No pharmacologic dilation · 848x848 · graded on the modified Davis scale · NIDEK AFC-230 fundus camera · 45° field of view · posterior pole photograph.
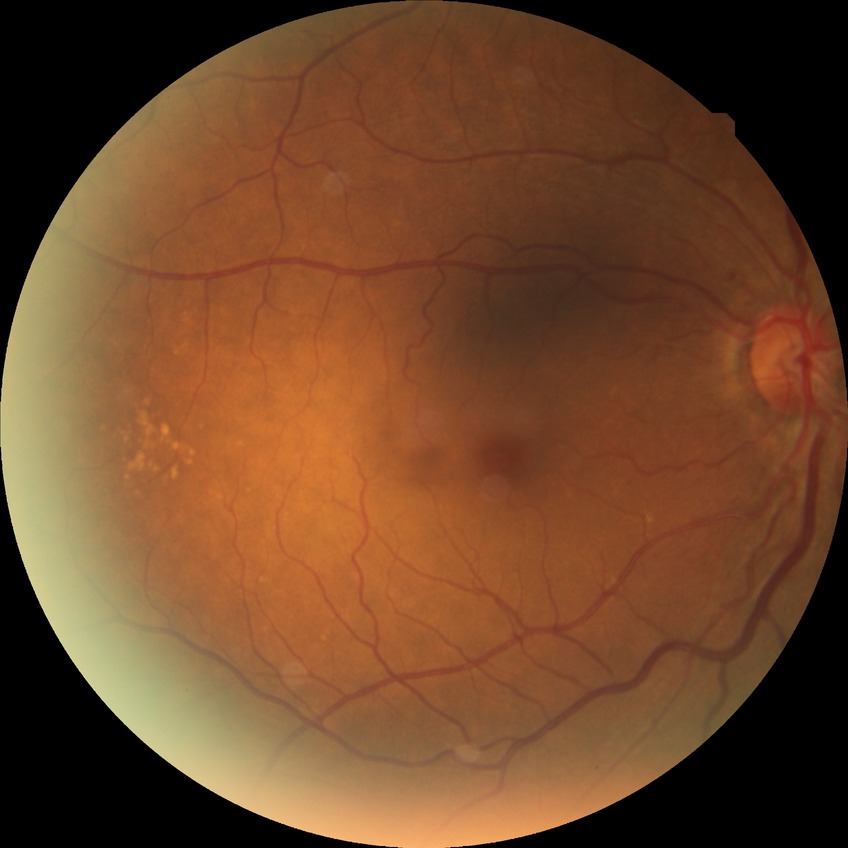

Diabetic retinopathy (DR) is NDR (no diabetic retinopathy).